Modified Davis grading: 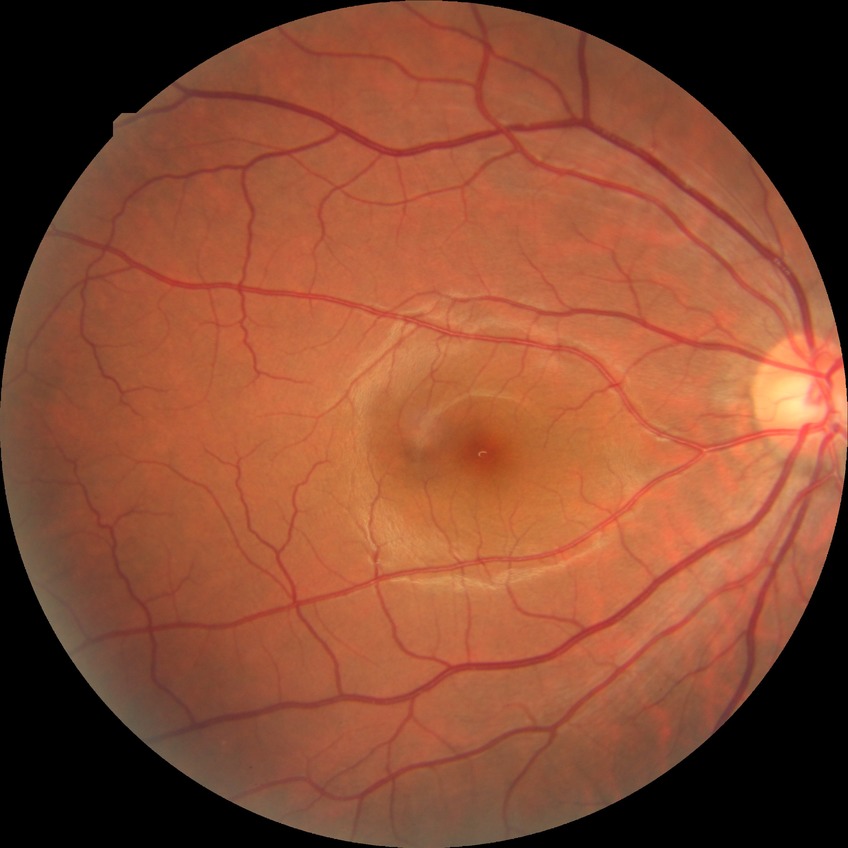 Diabetic retinopathy (DR) is NDR (no diabetic retinopathy).